45° FOV
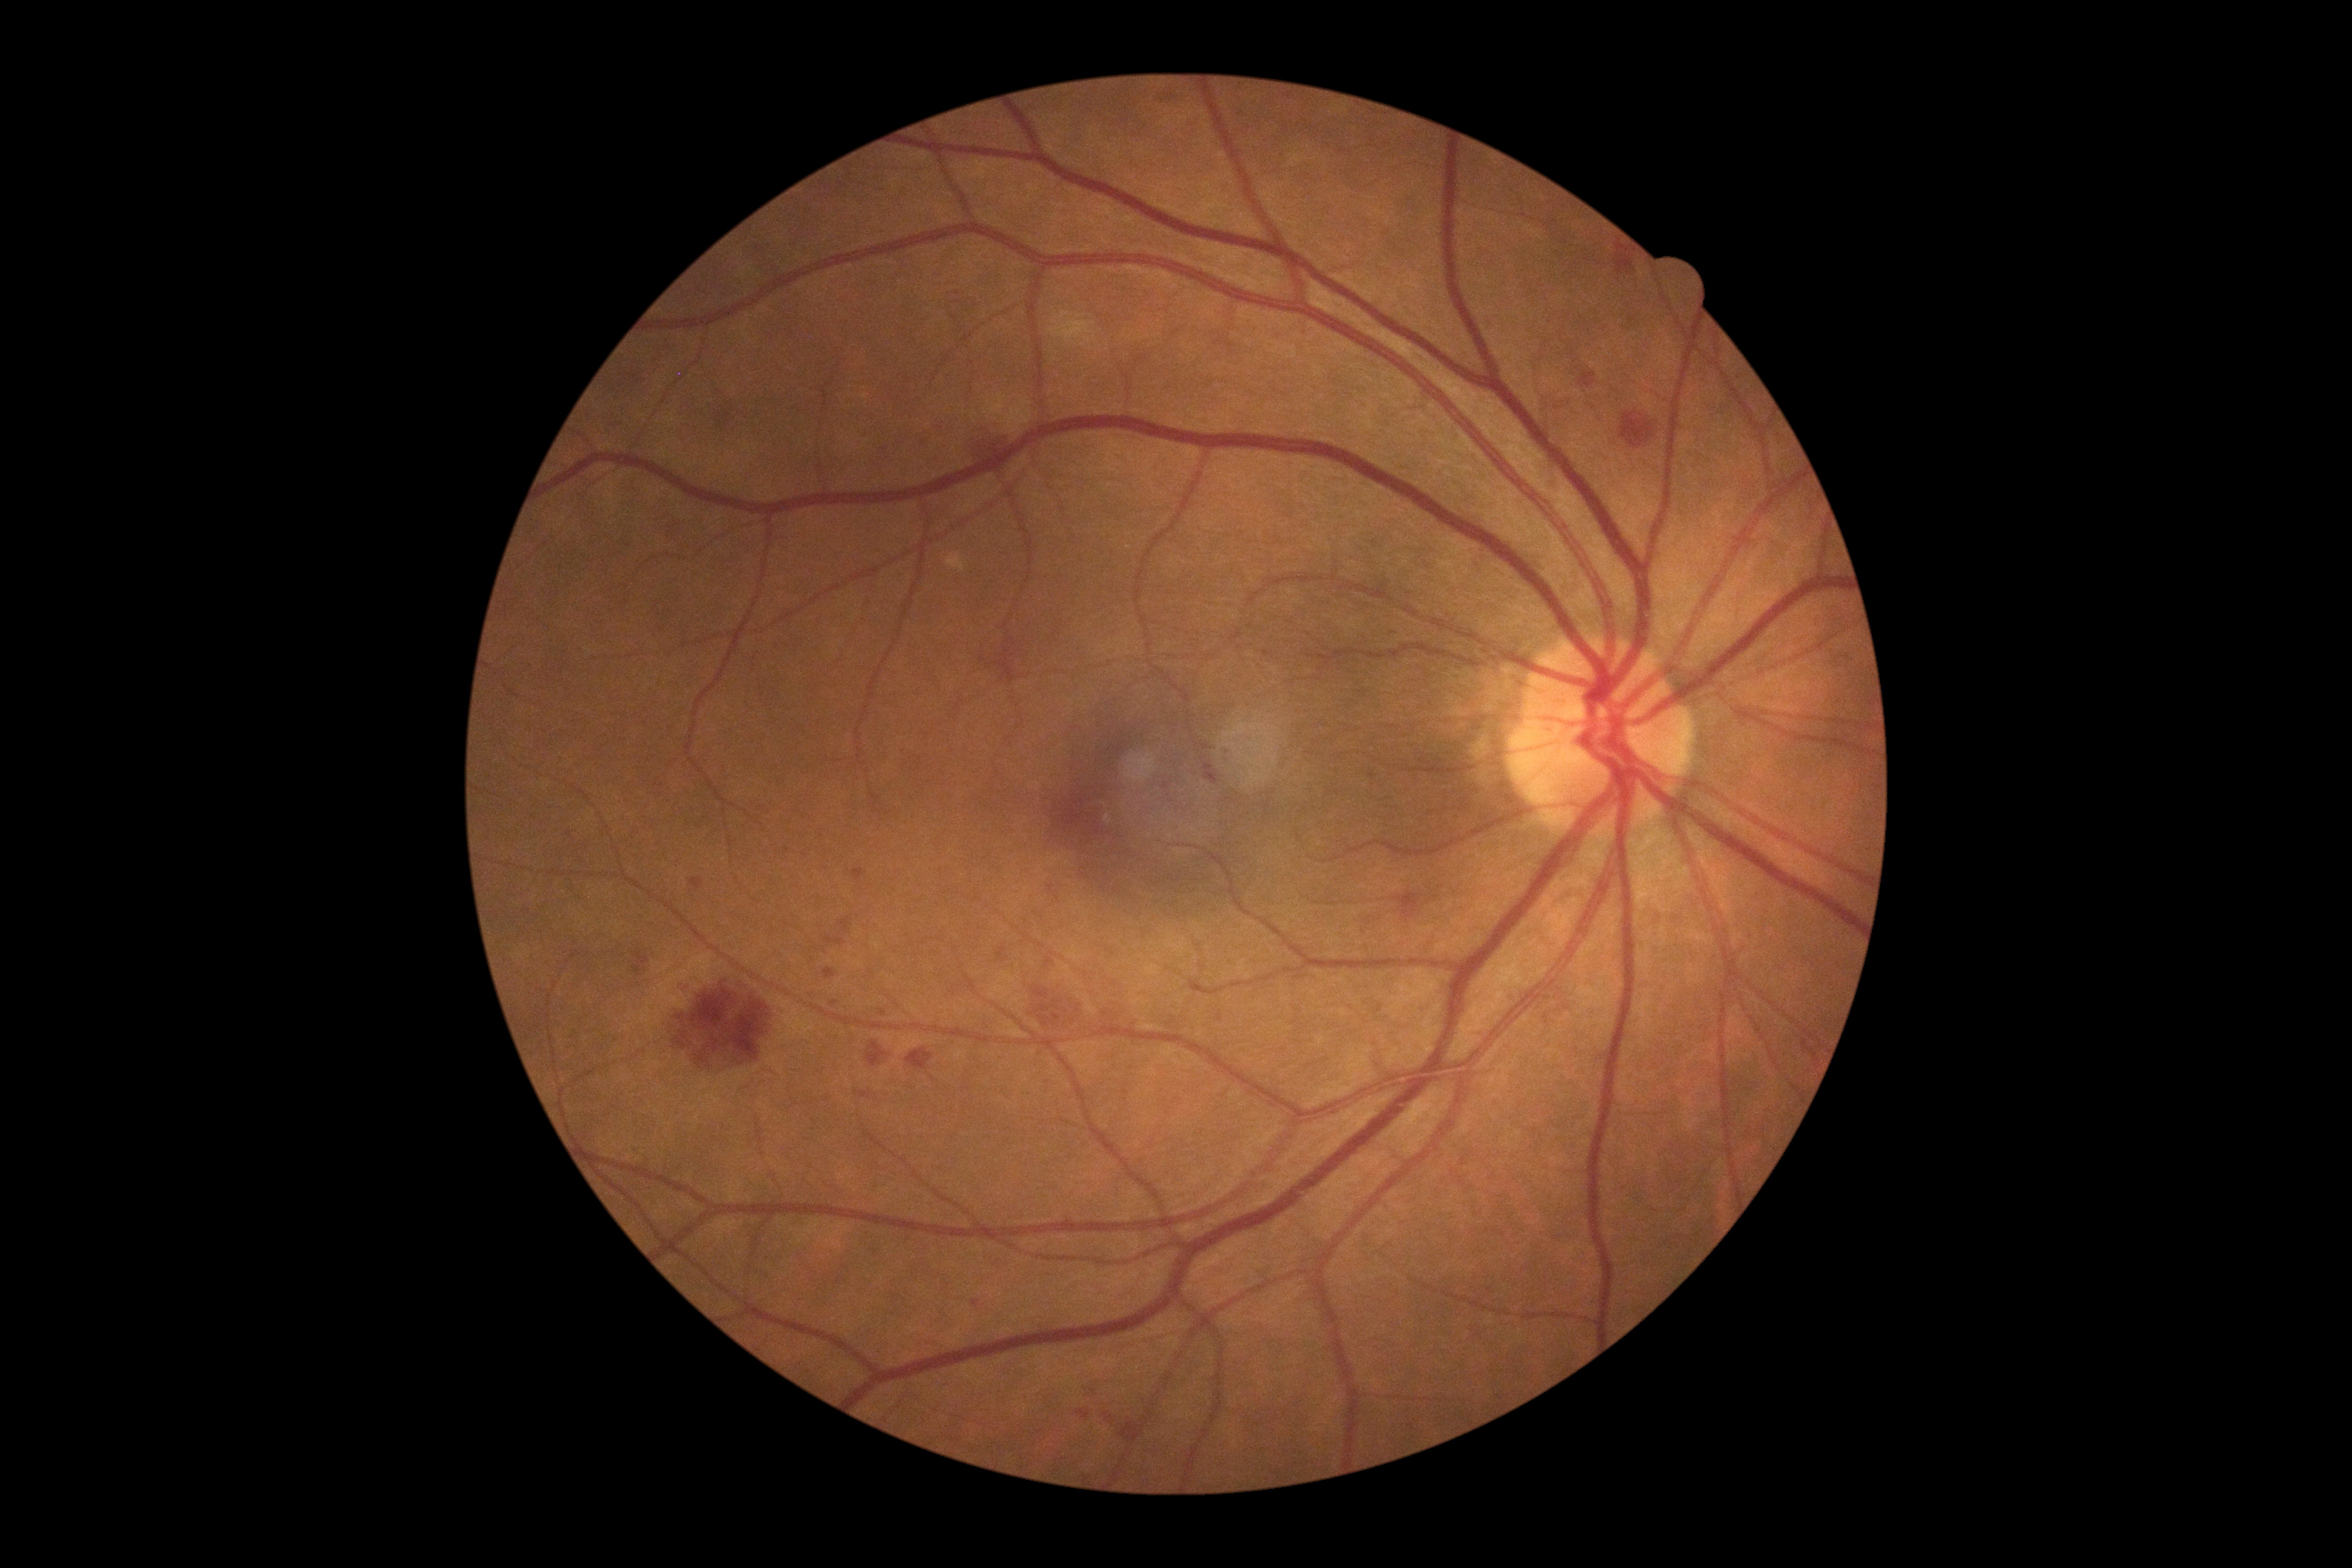 Retinopathy: 2 — more than just microaneurysms but less than severe NPDR.